Image size 640x480 · RetCam wide-field infant fundus image
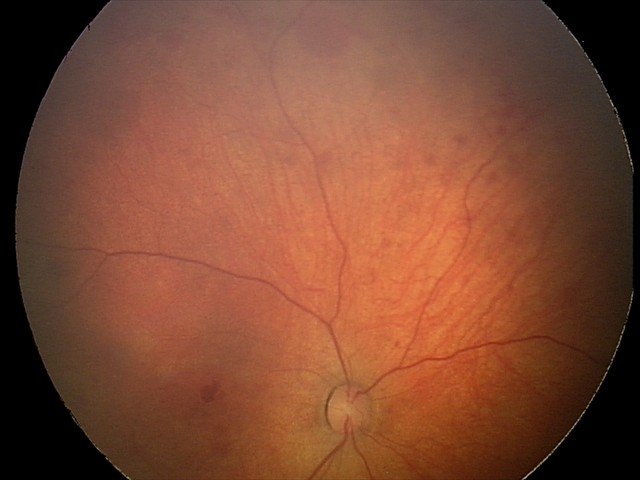
Screening series with retinal hemorrhages.